2352x1568: 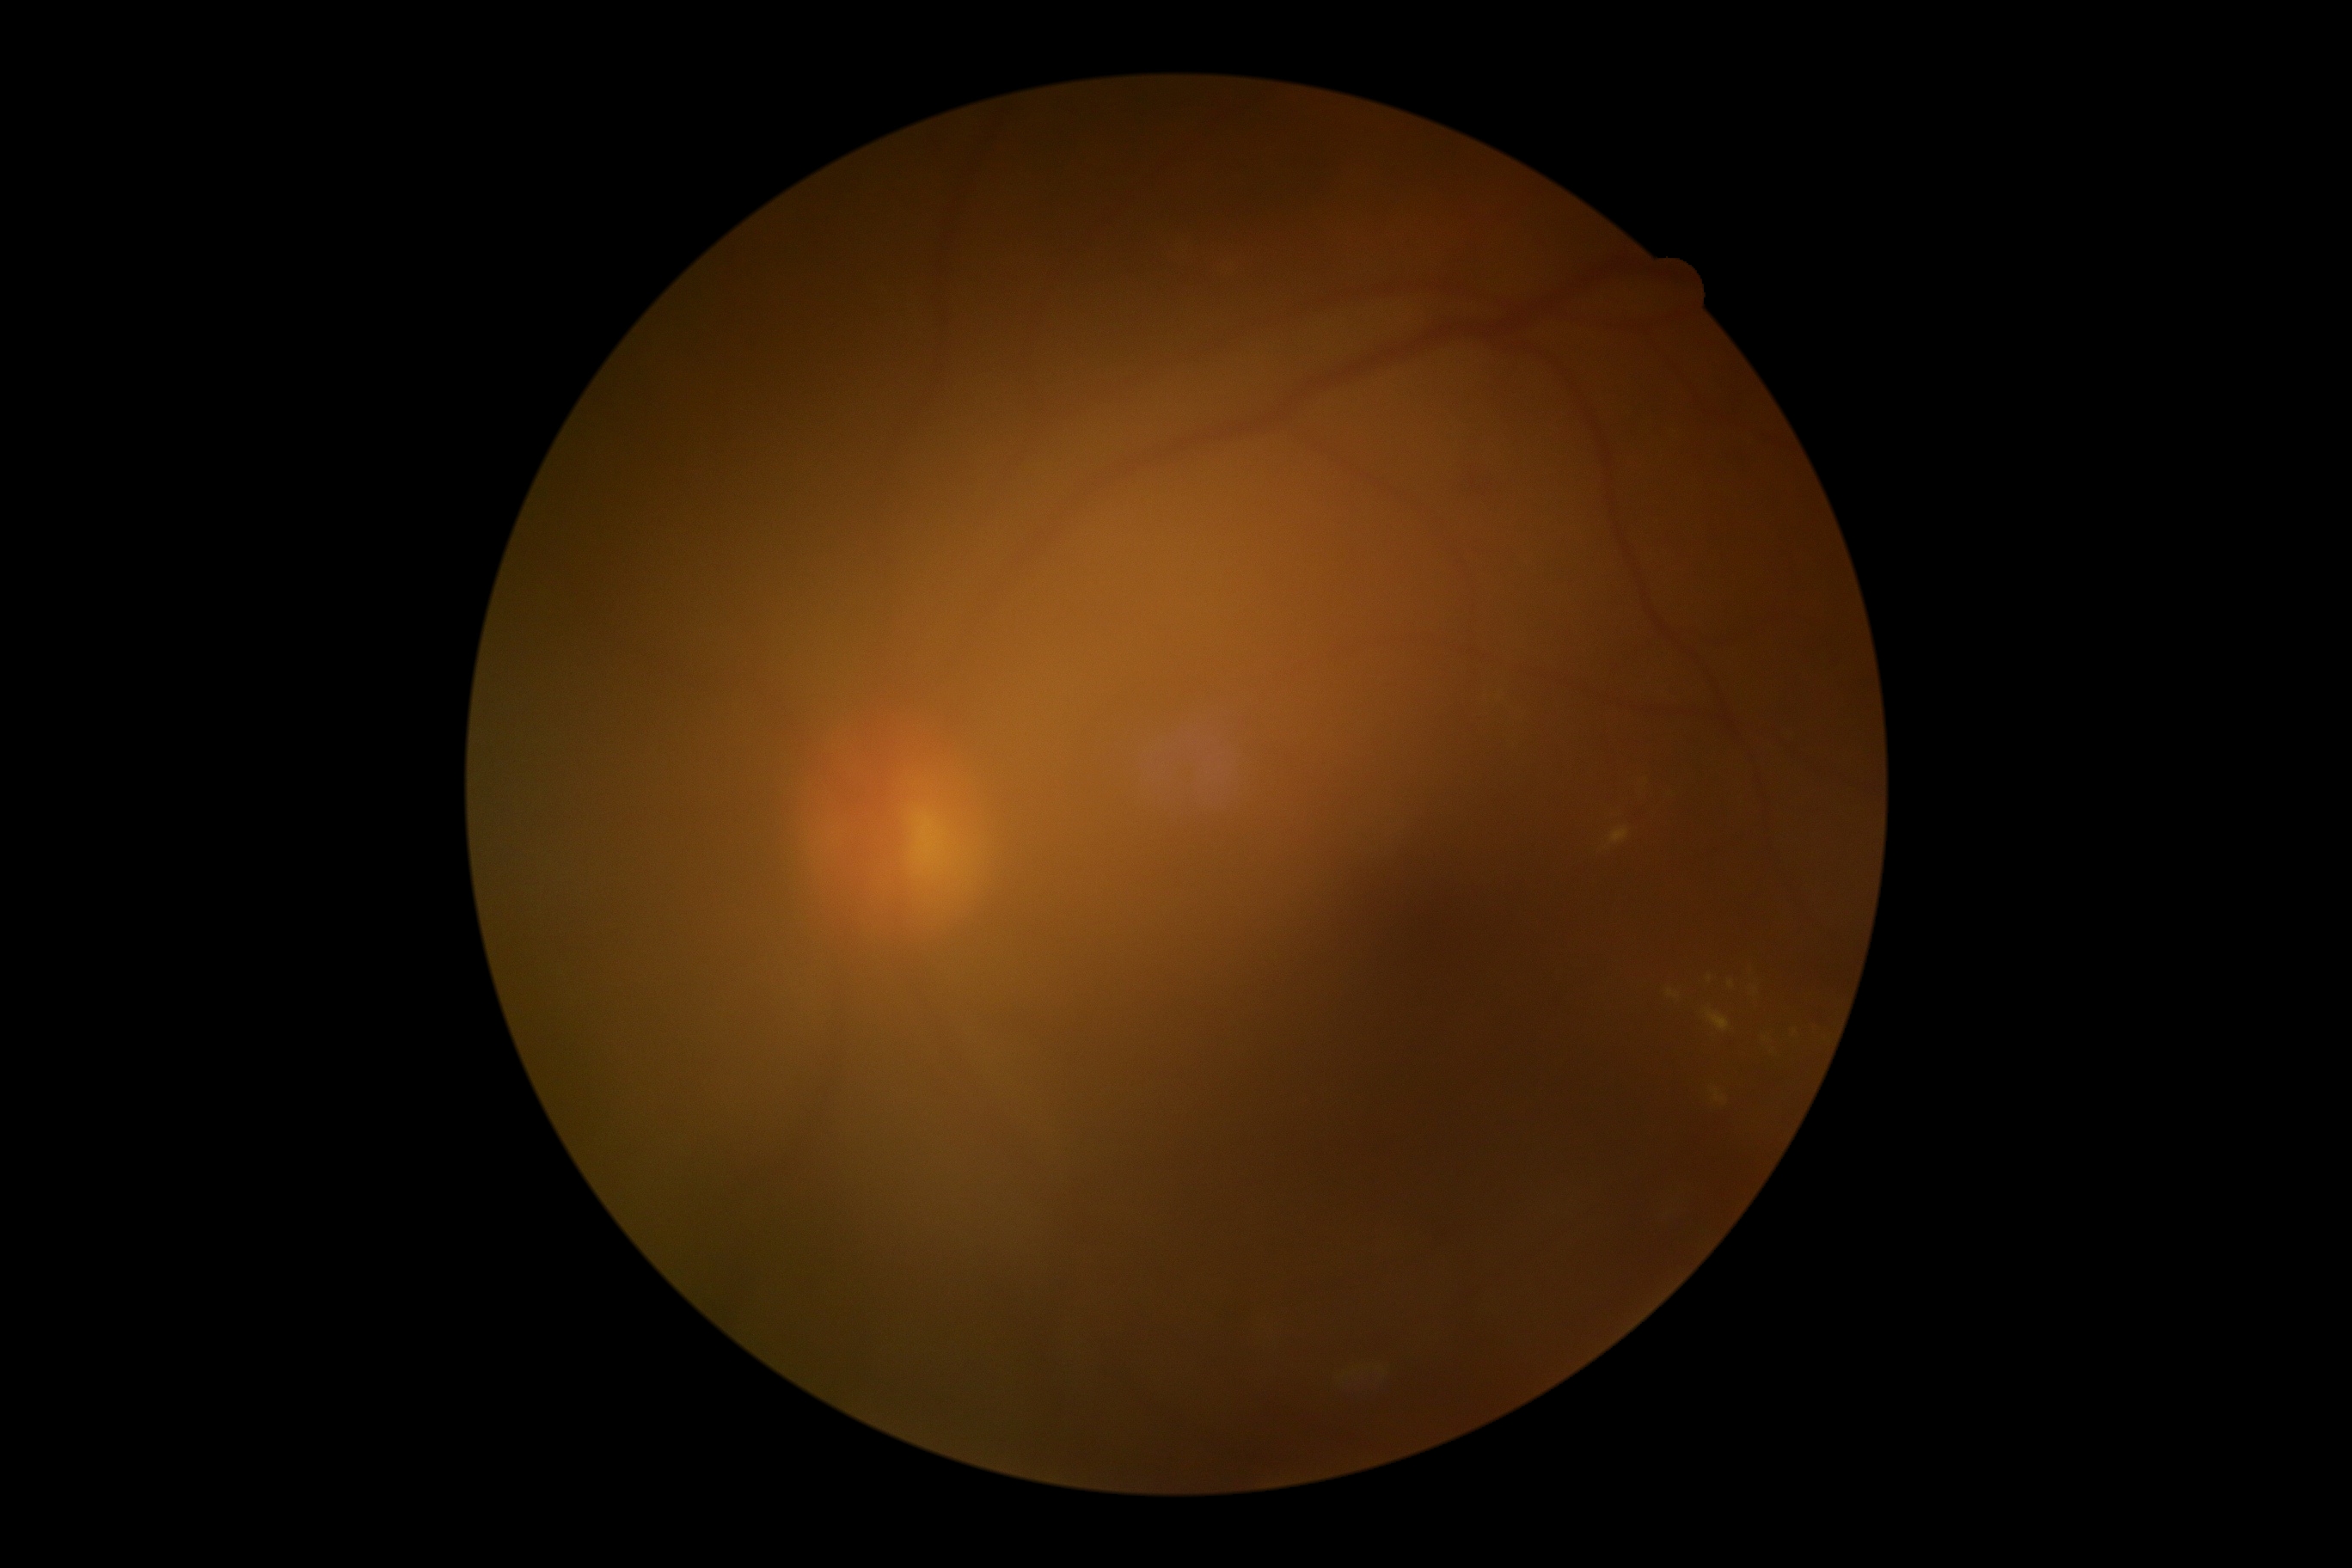

DR grade: 2